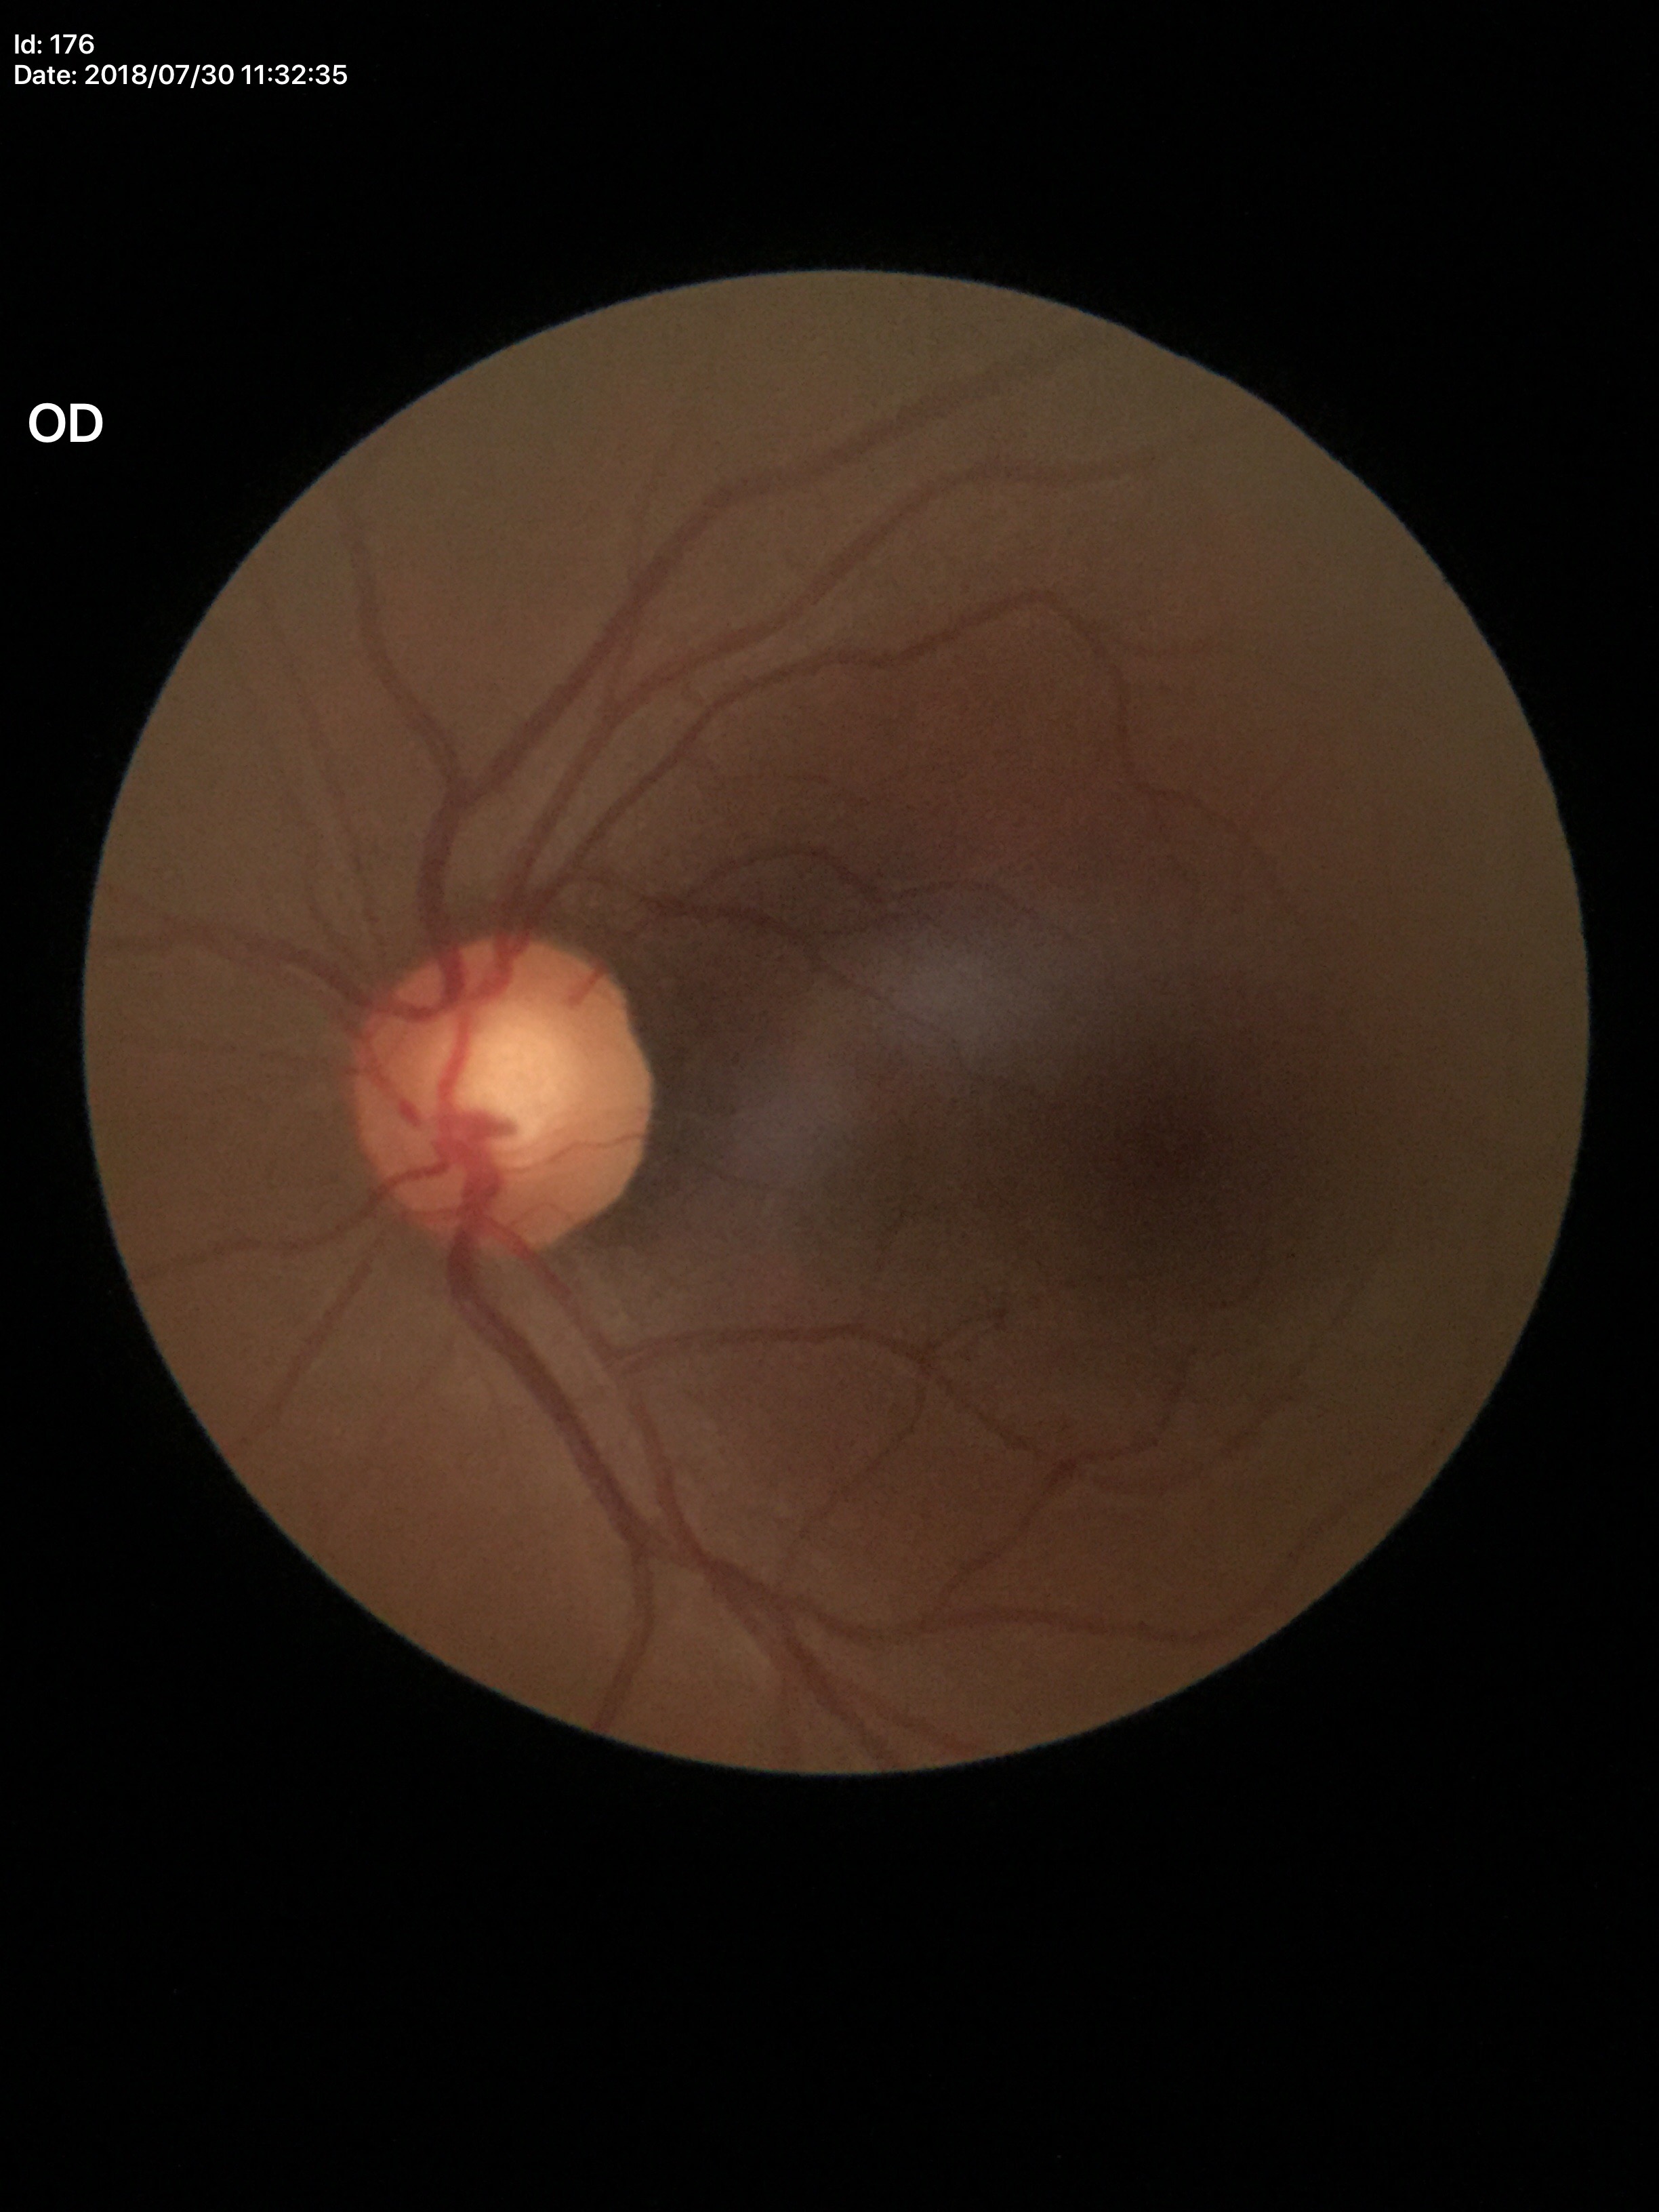 Annotations:
- horizontal cup-disc ratio (HCDR): 0.56
- vertical C/D ratio (VCDR): 0.58
- Glaucoma assessment: no suspicious findings